Axial length: 24.1 mm; 30-year-old patient; 30° field of view
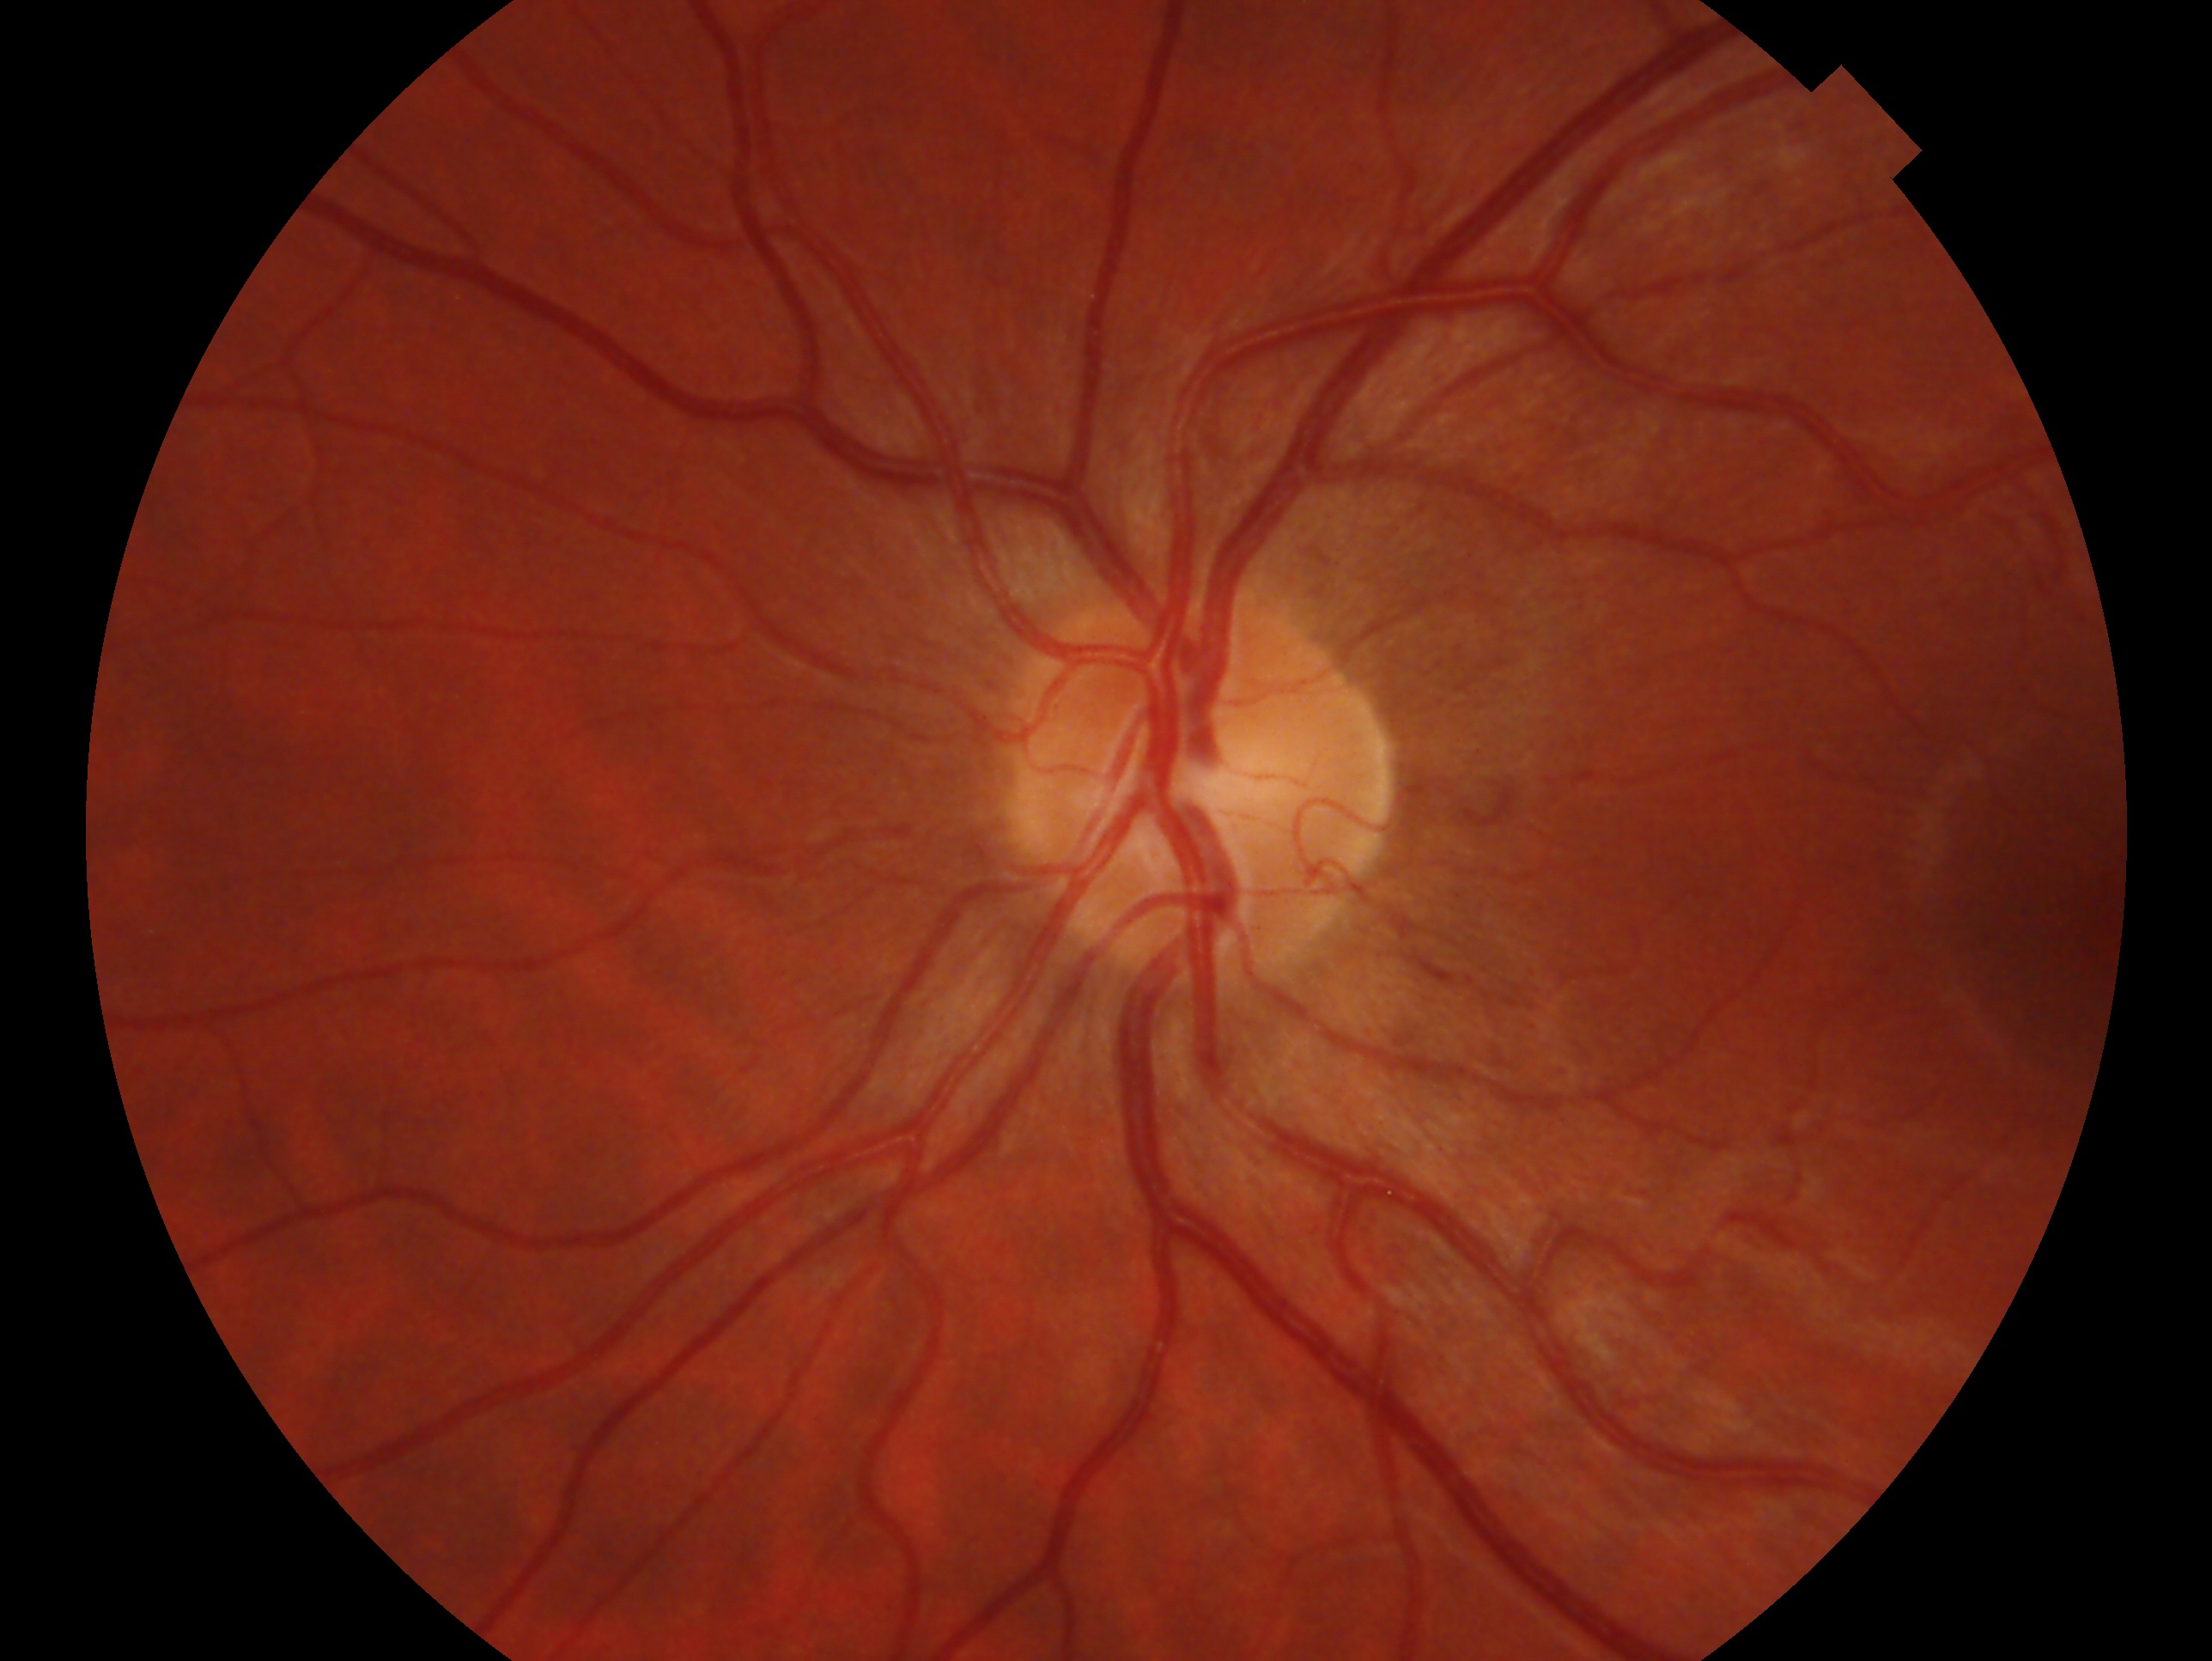

Glaucoma diagnosis — no signs of glaucoma. This is the left eye.